Pupil-dilated · 2228x1652 · captured on a Topcon TRC-50DX fundus camera · 50-degree field of view · CFP — 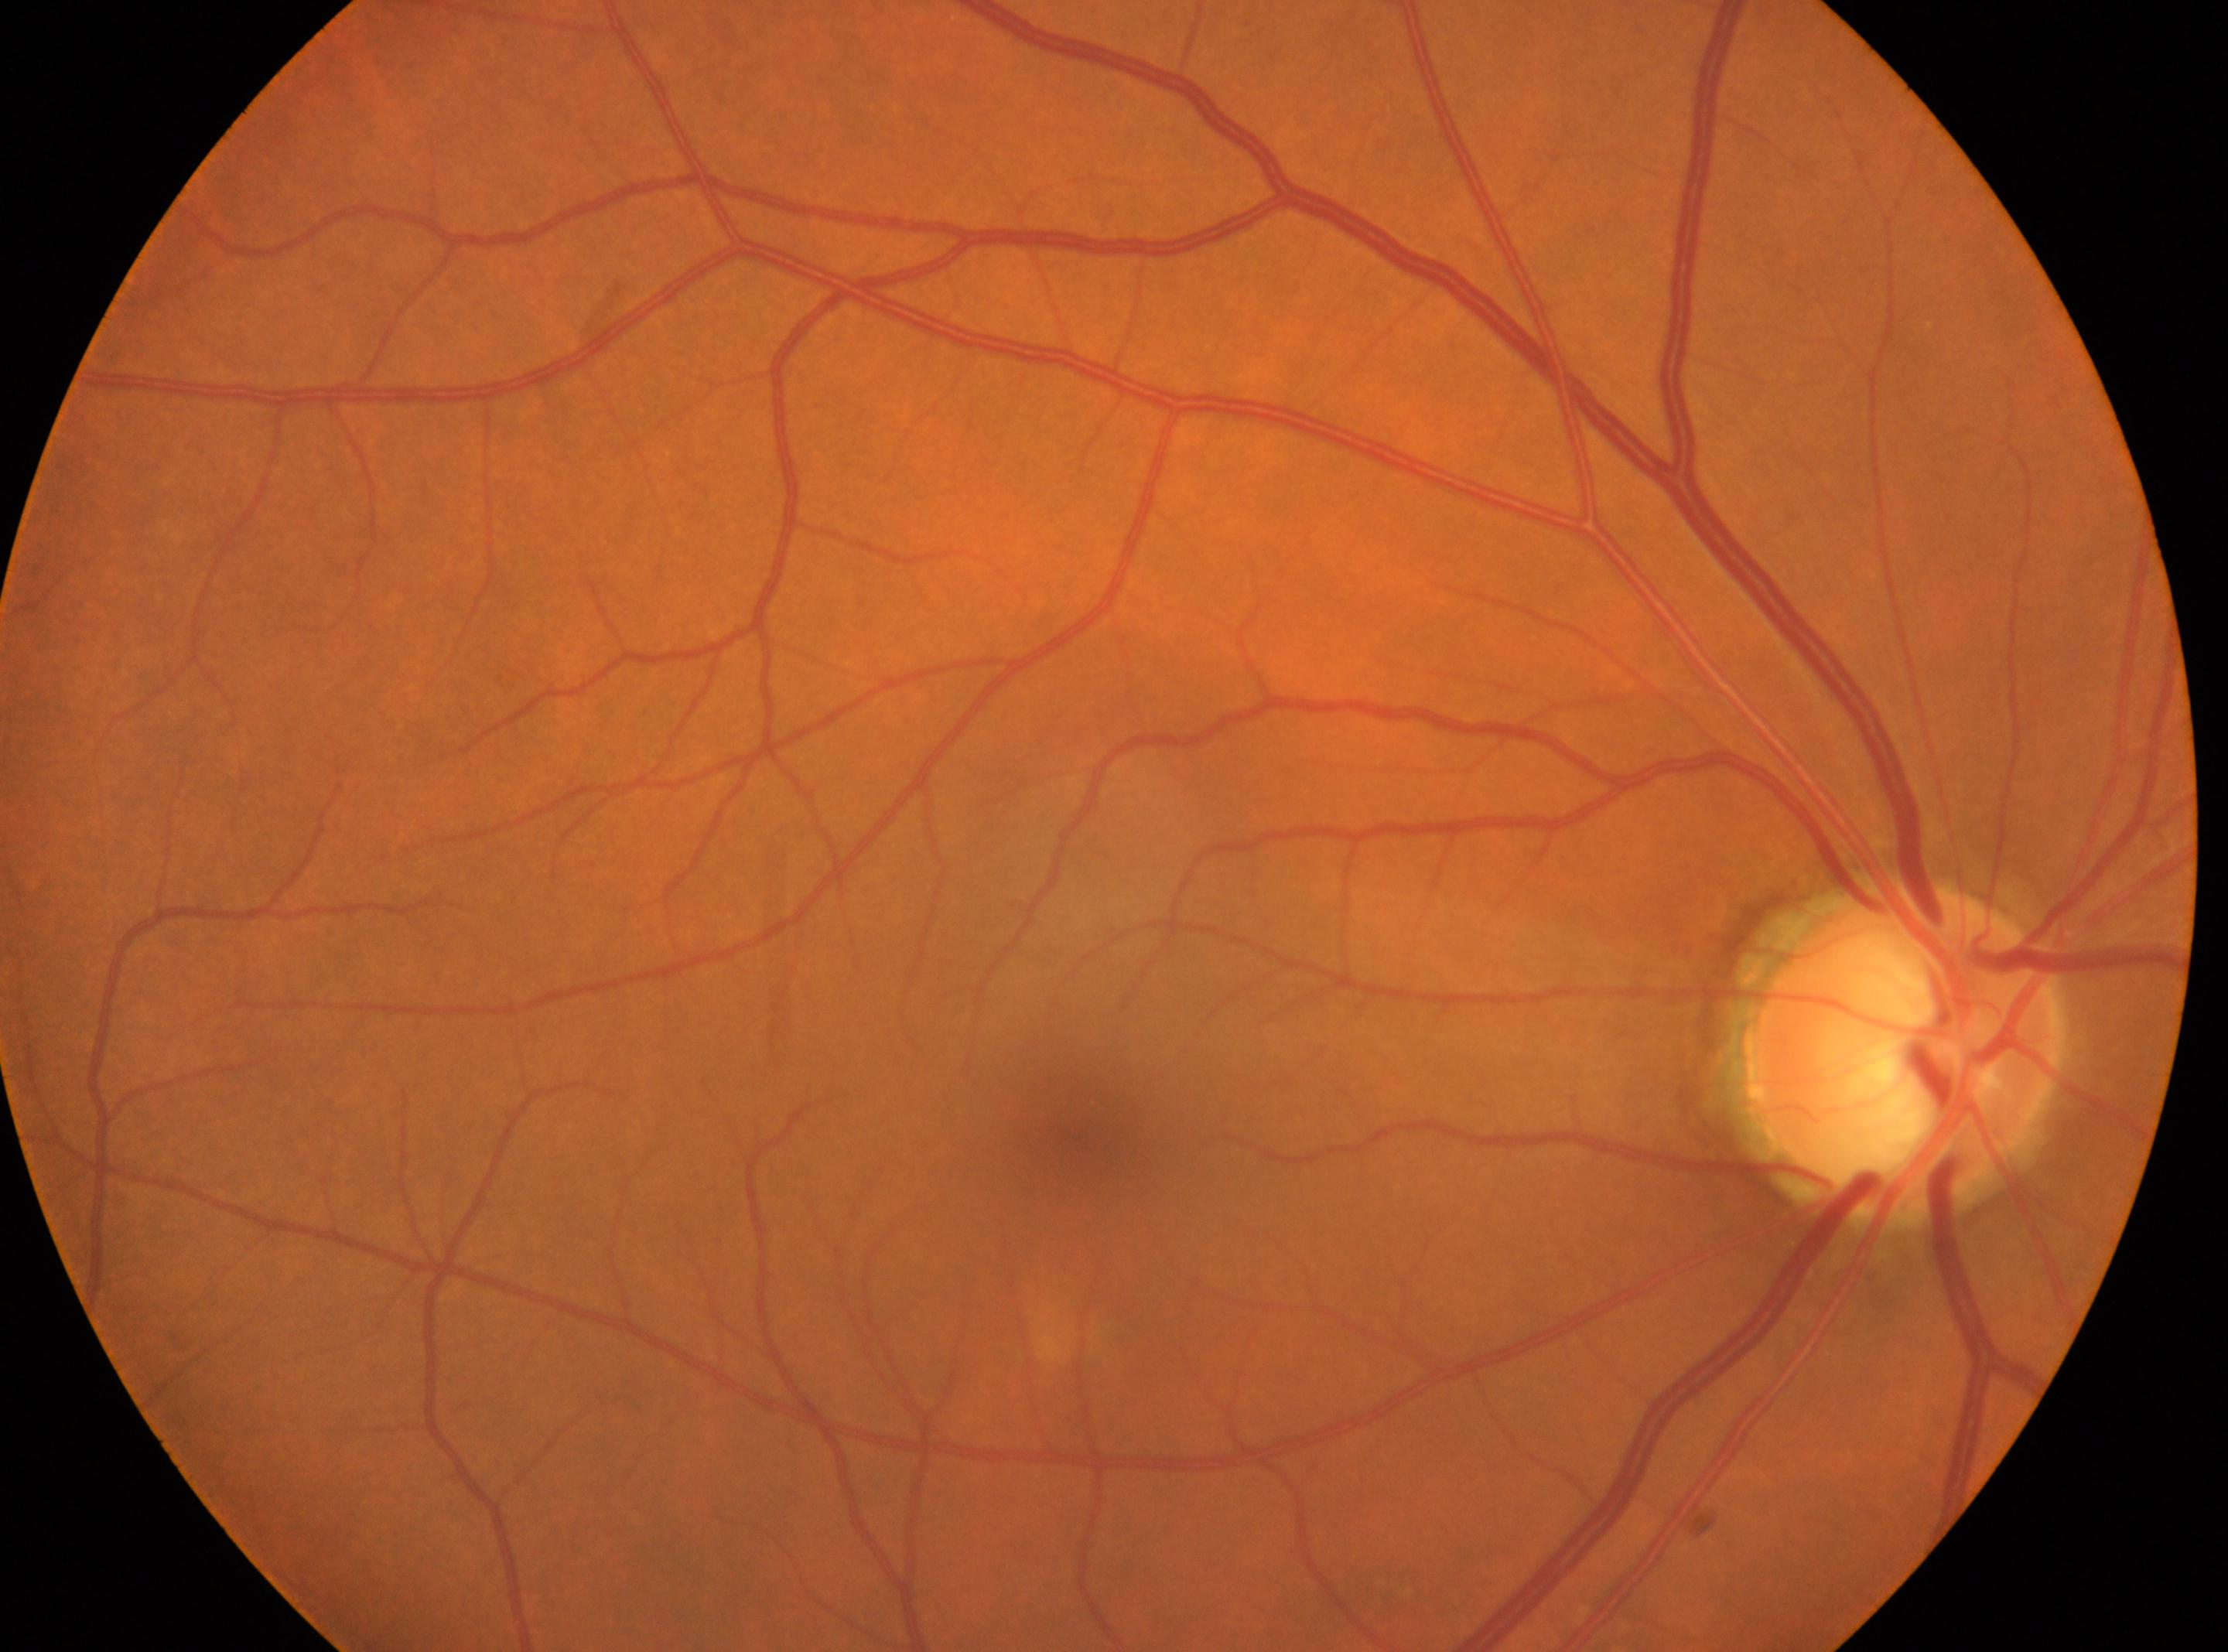
Foveal center located at x=1077, y=1142. ONH located at x=1901, y=1047. Eye: oculus dexter. Diabetic retinopathy (DR): grade 0 (no apparent retinopathy).